2352x1568px — 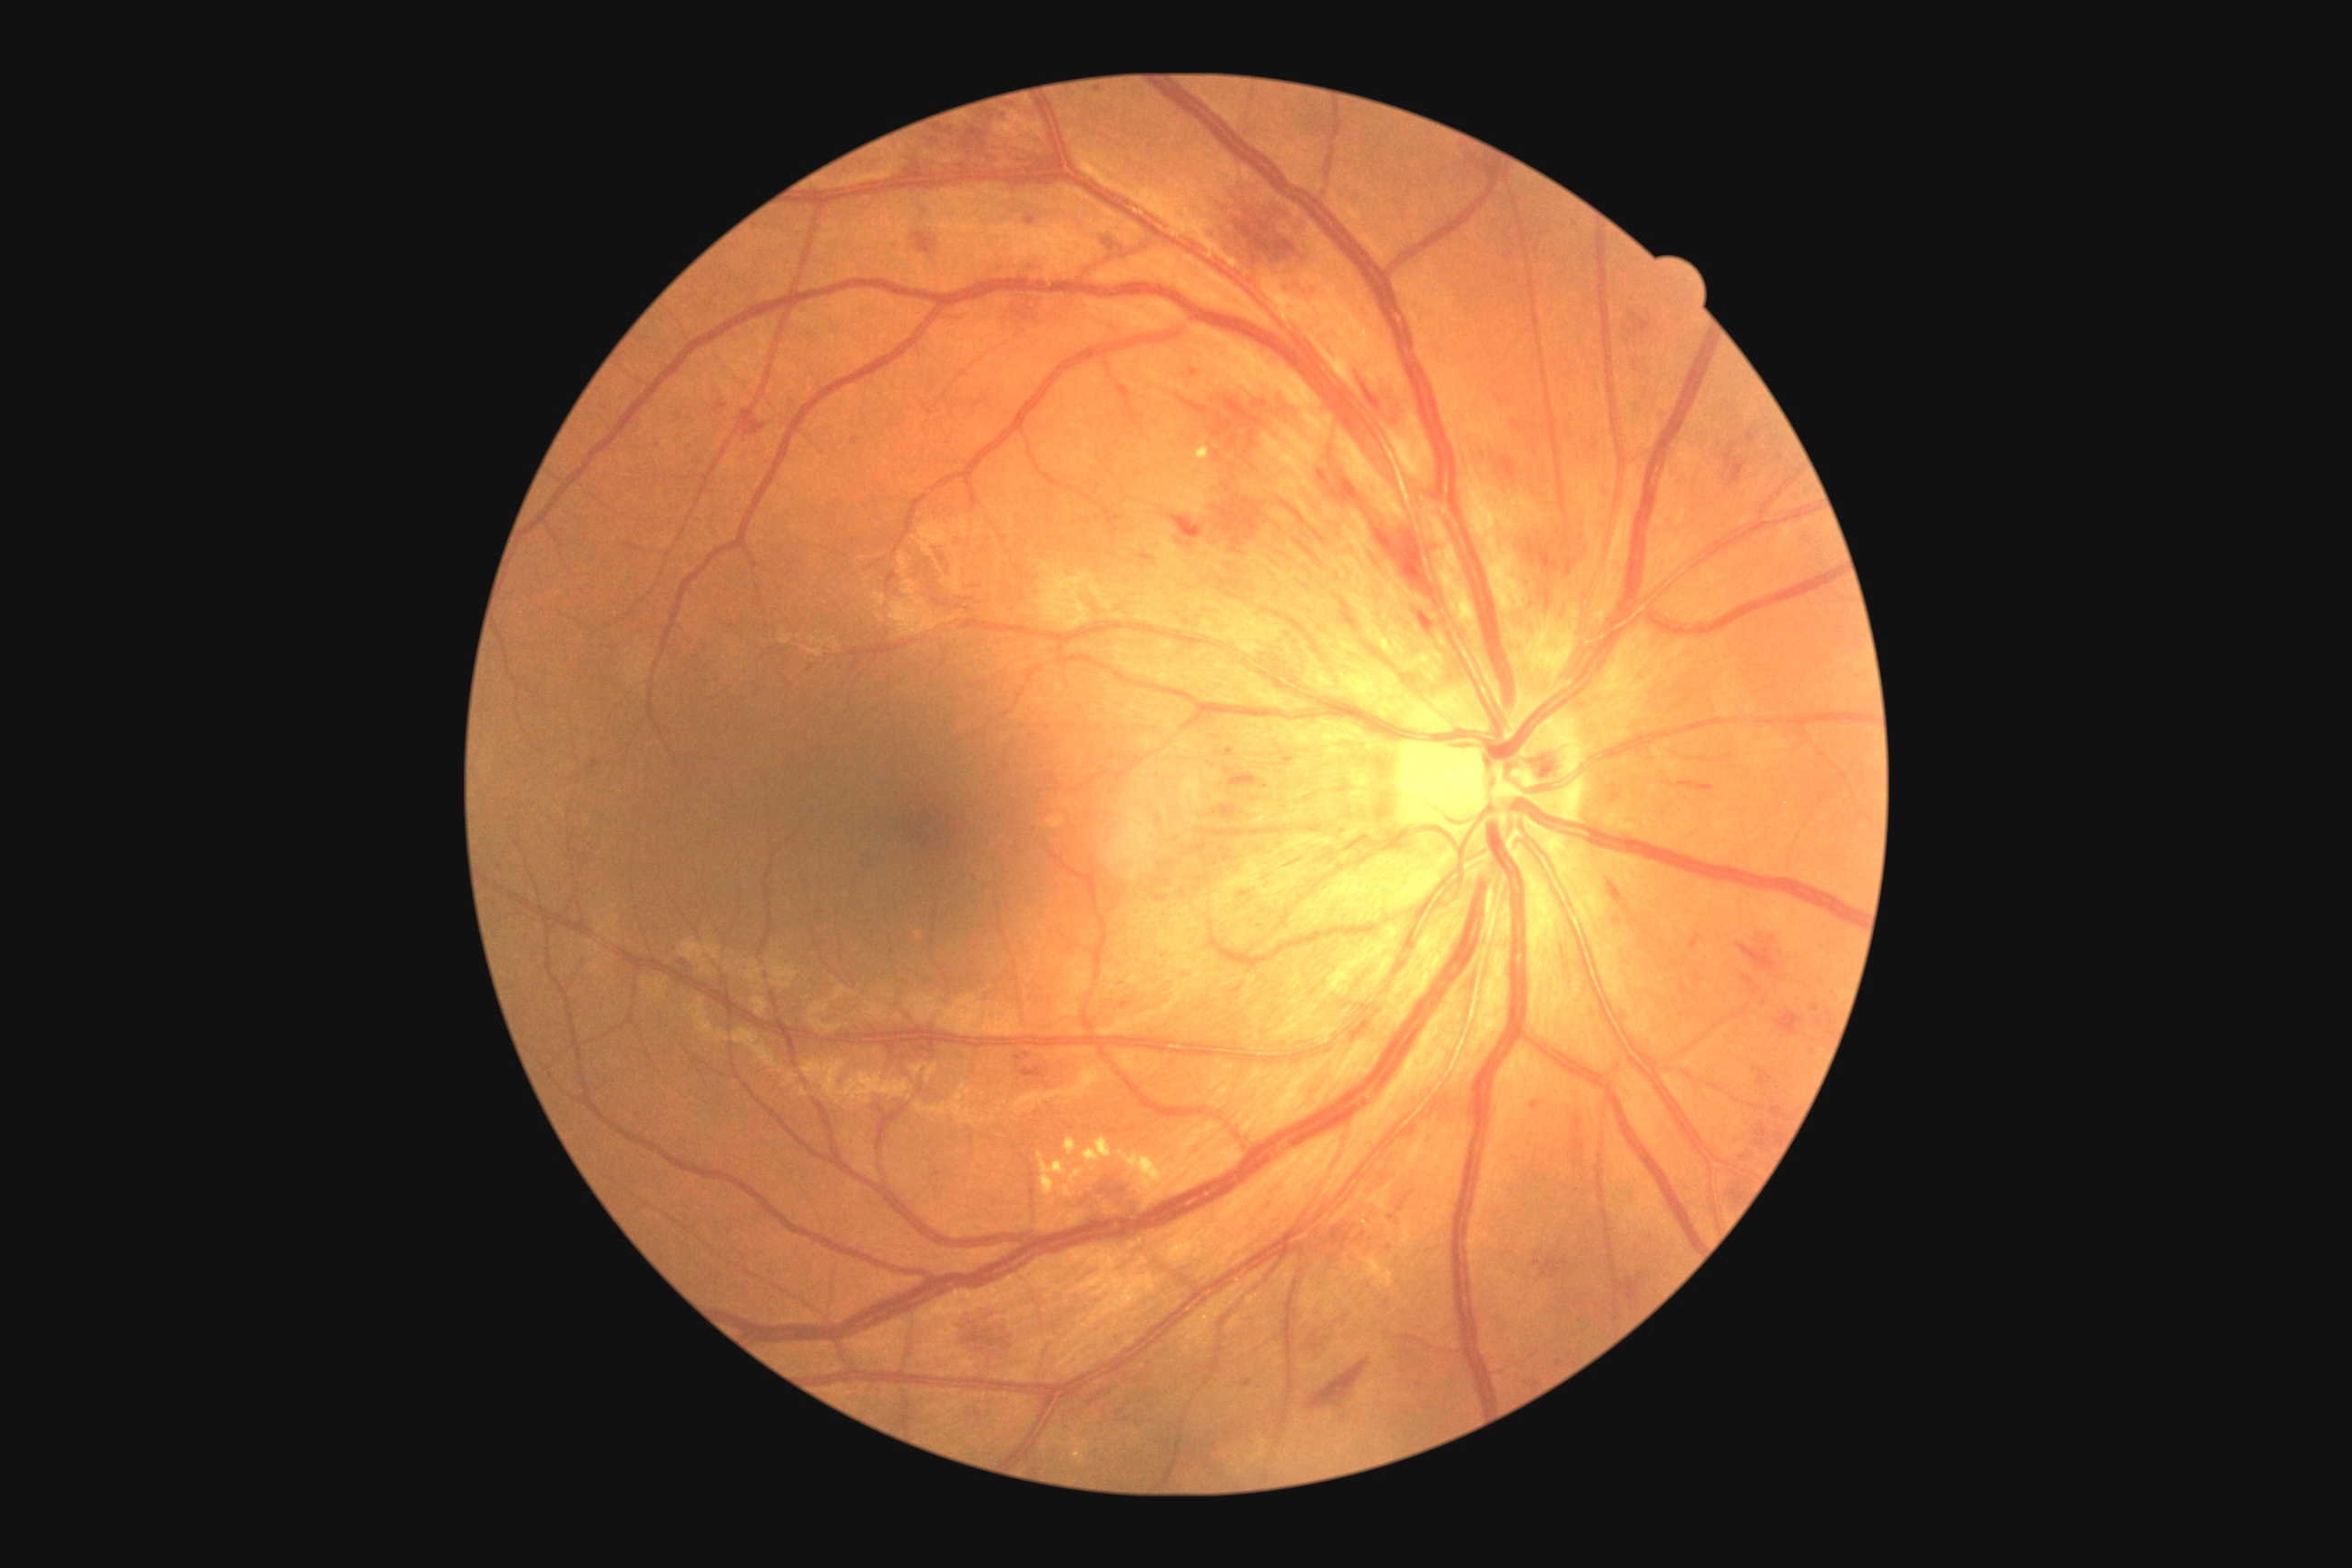

retinopathy grade@moderate non-proliferative diabetic retinopathy (2).